FOV: 30 degrees · disc-centered field
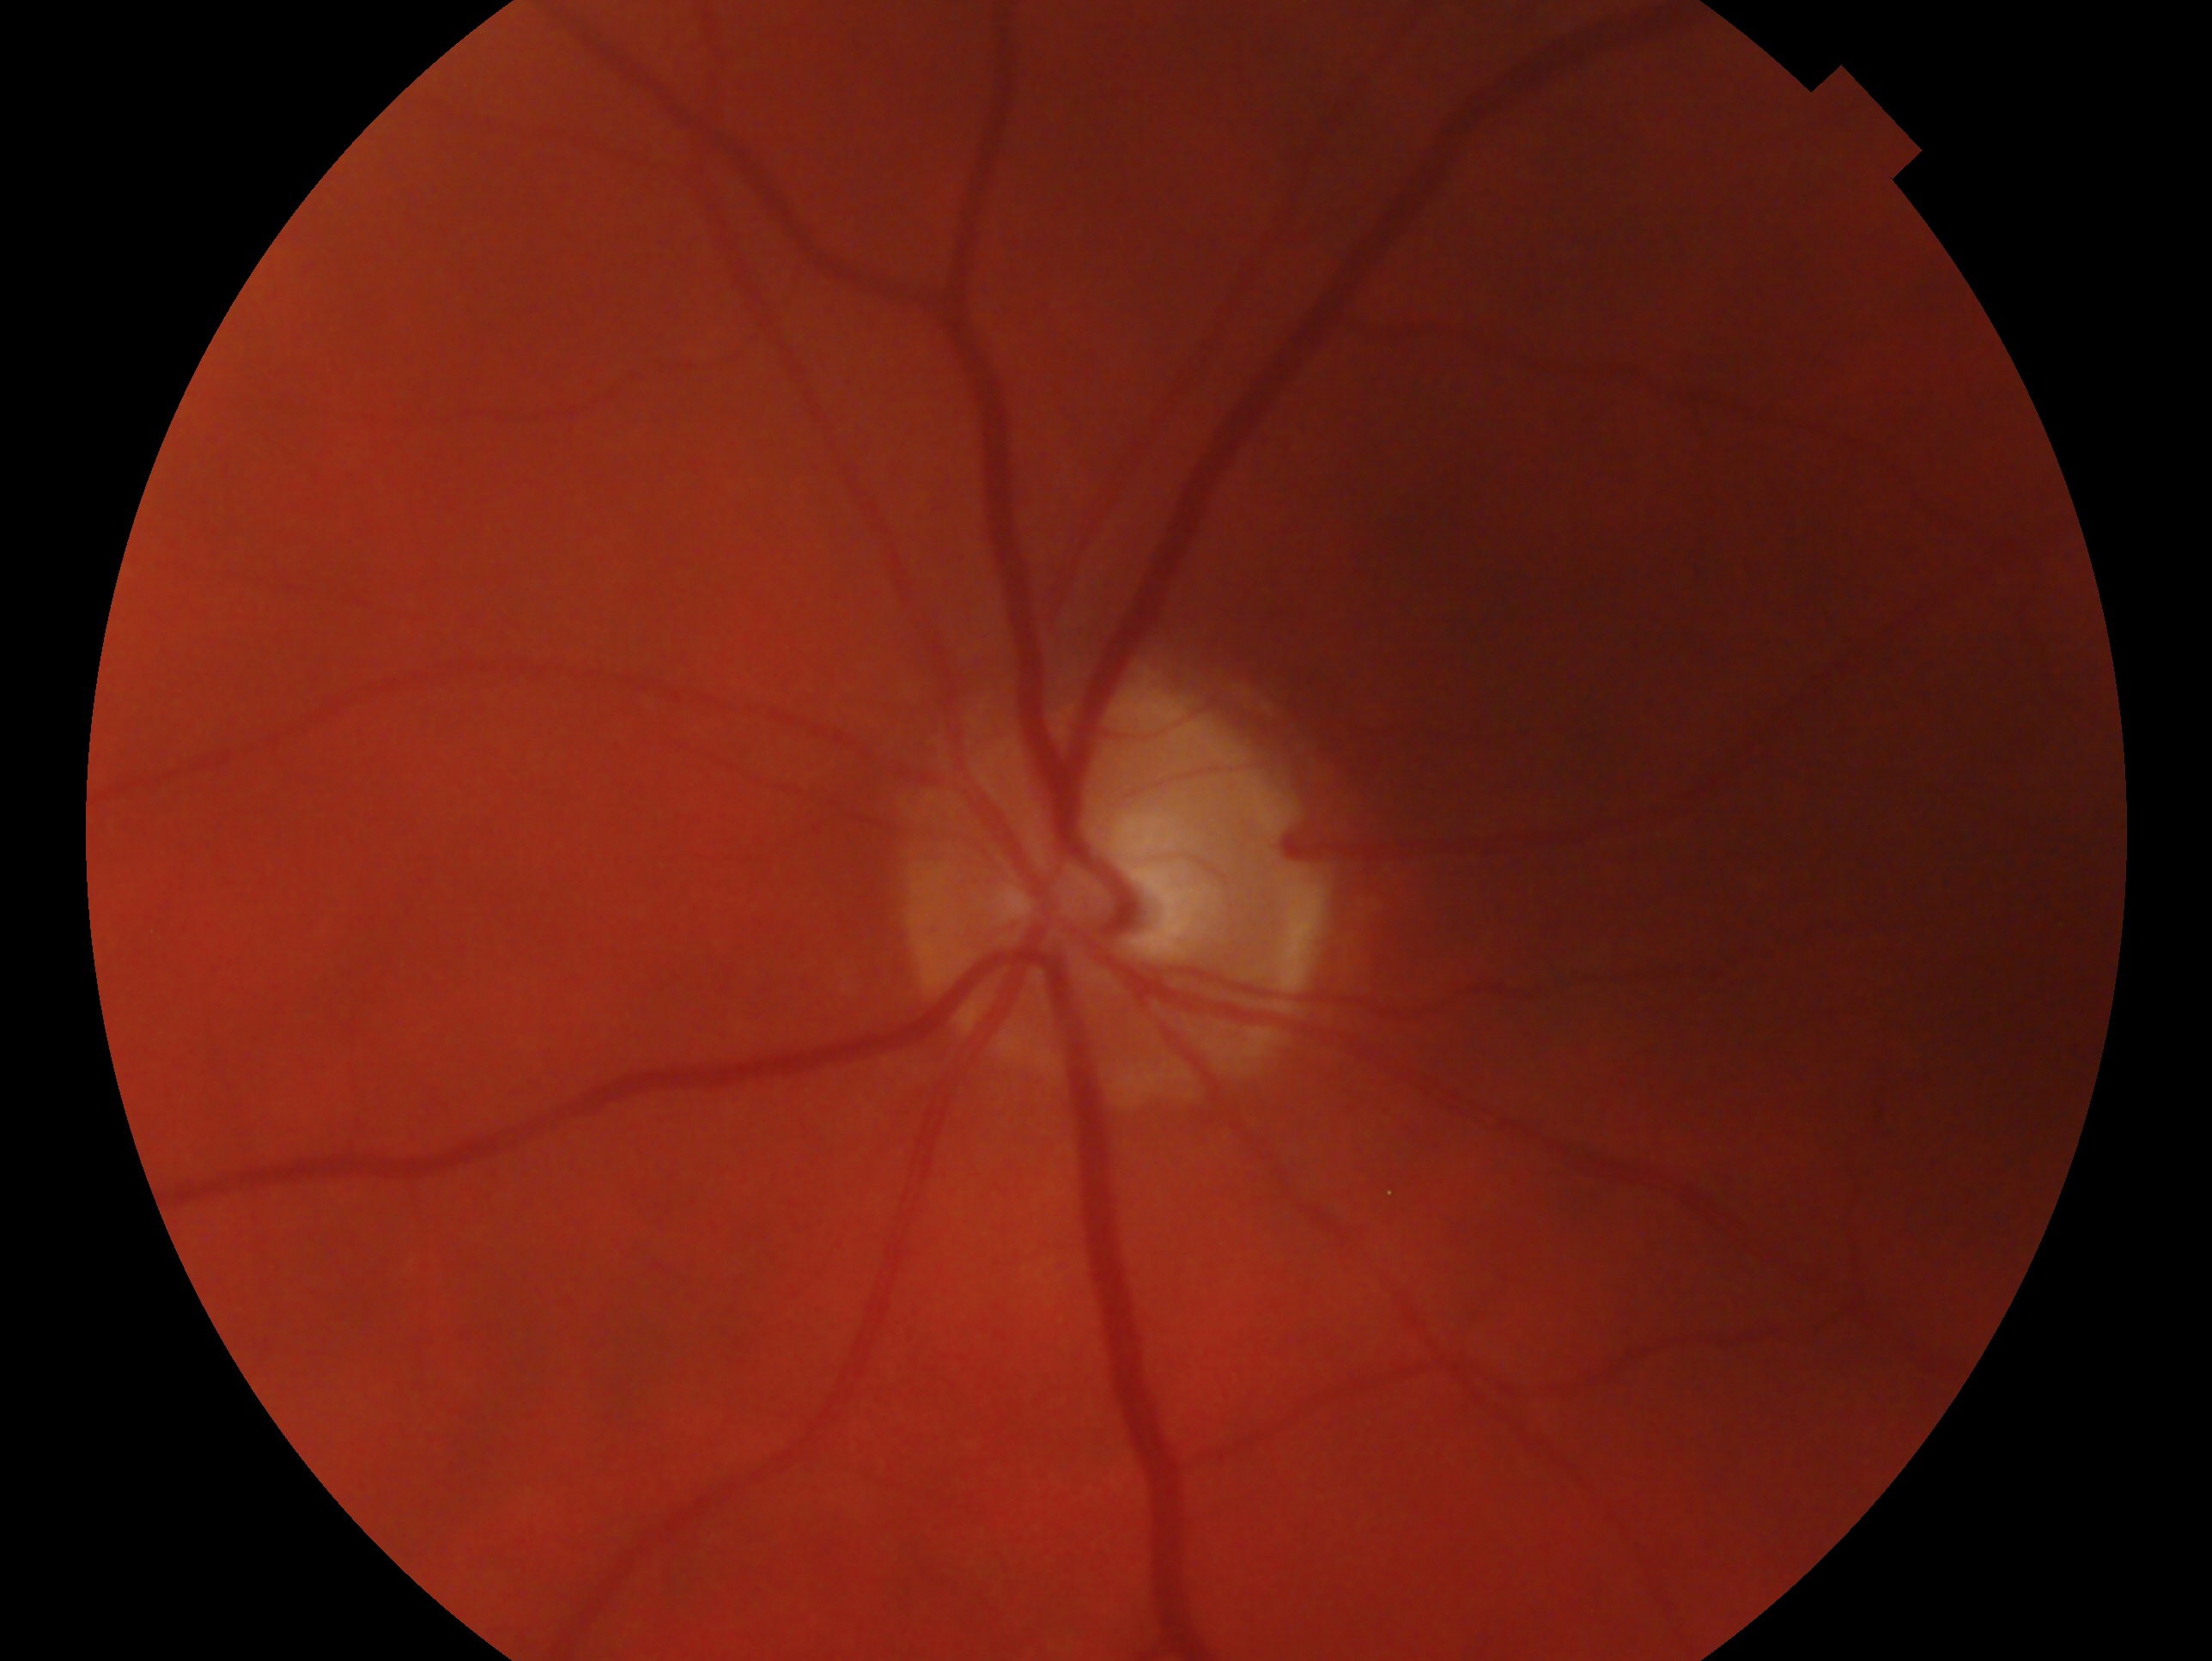 eye: OS
glaucoma diagnosis: cannot be excluded